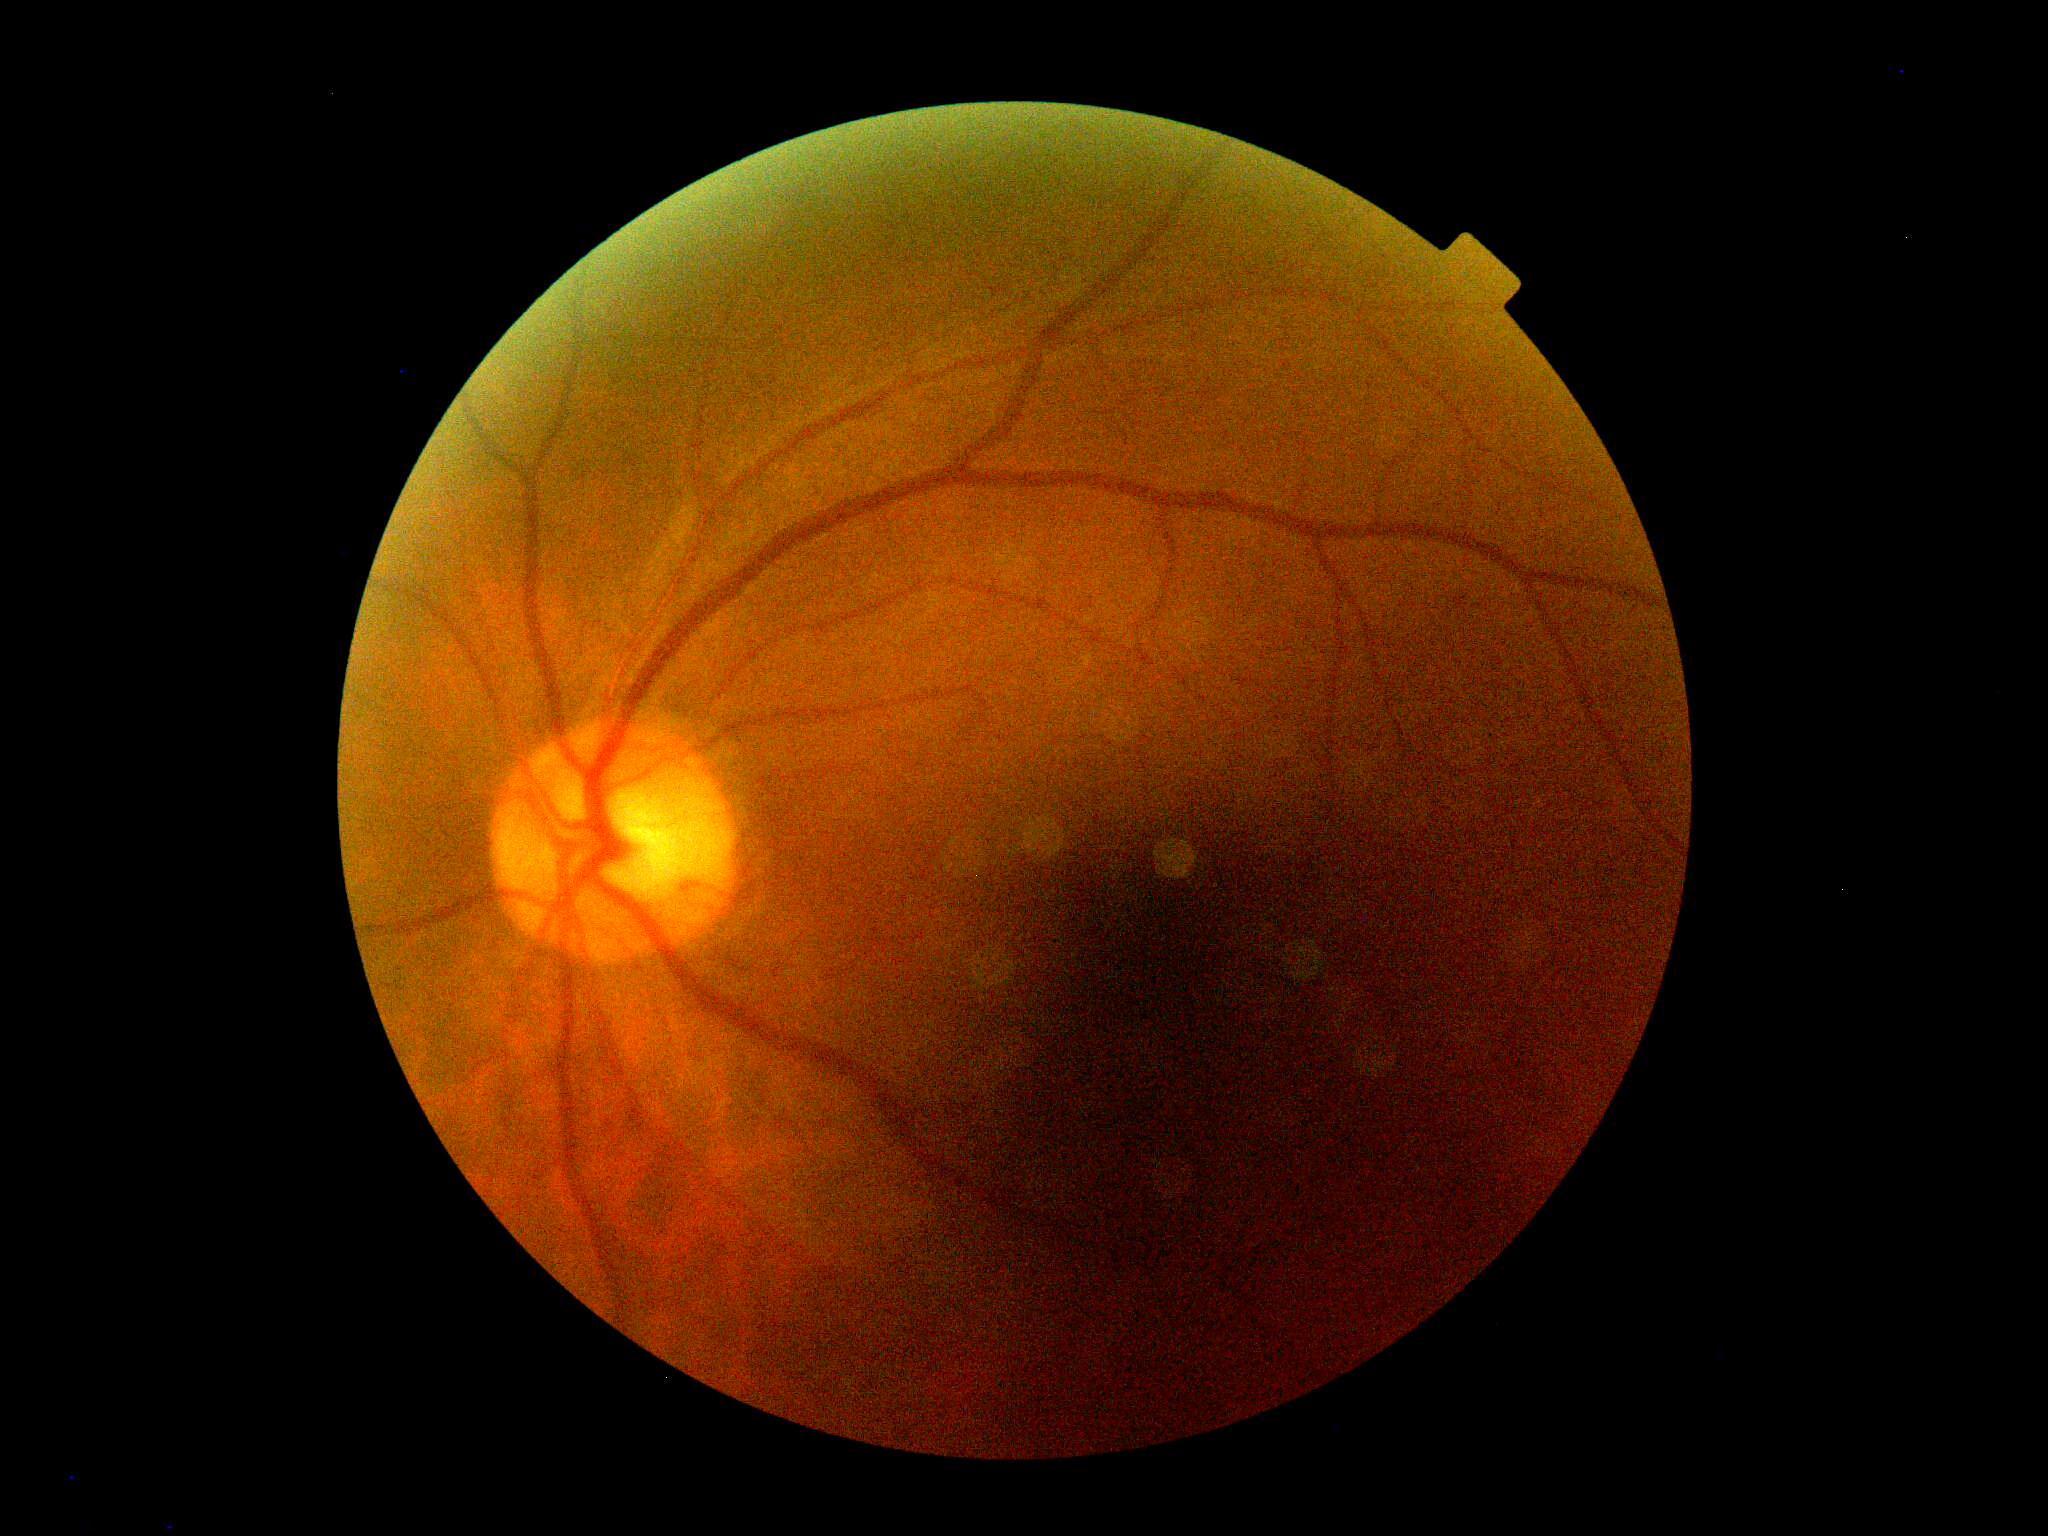 DR: grade 0.